Camera: Topcon TRC-NW8: 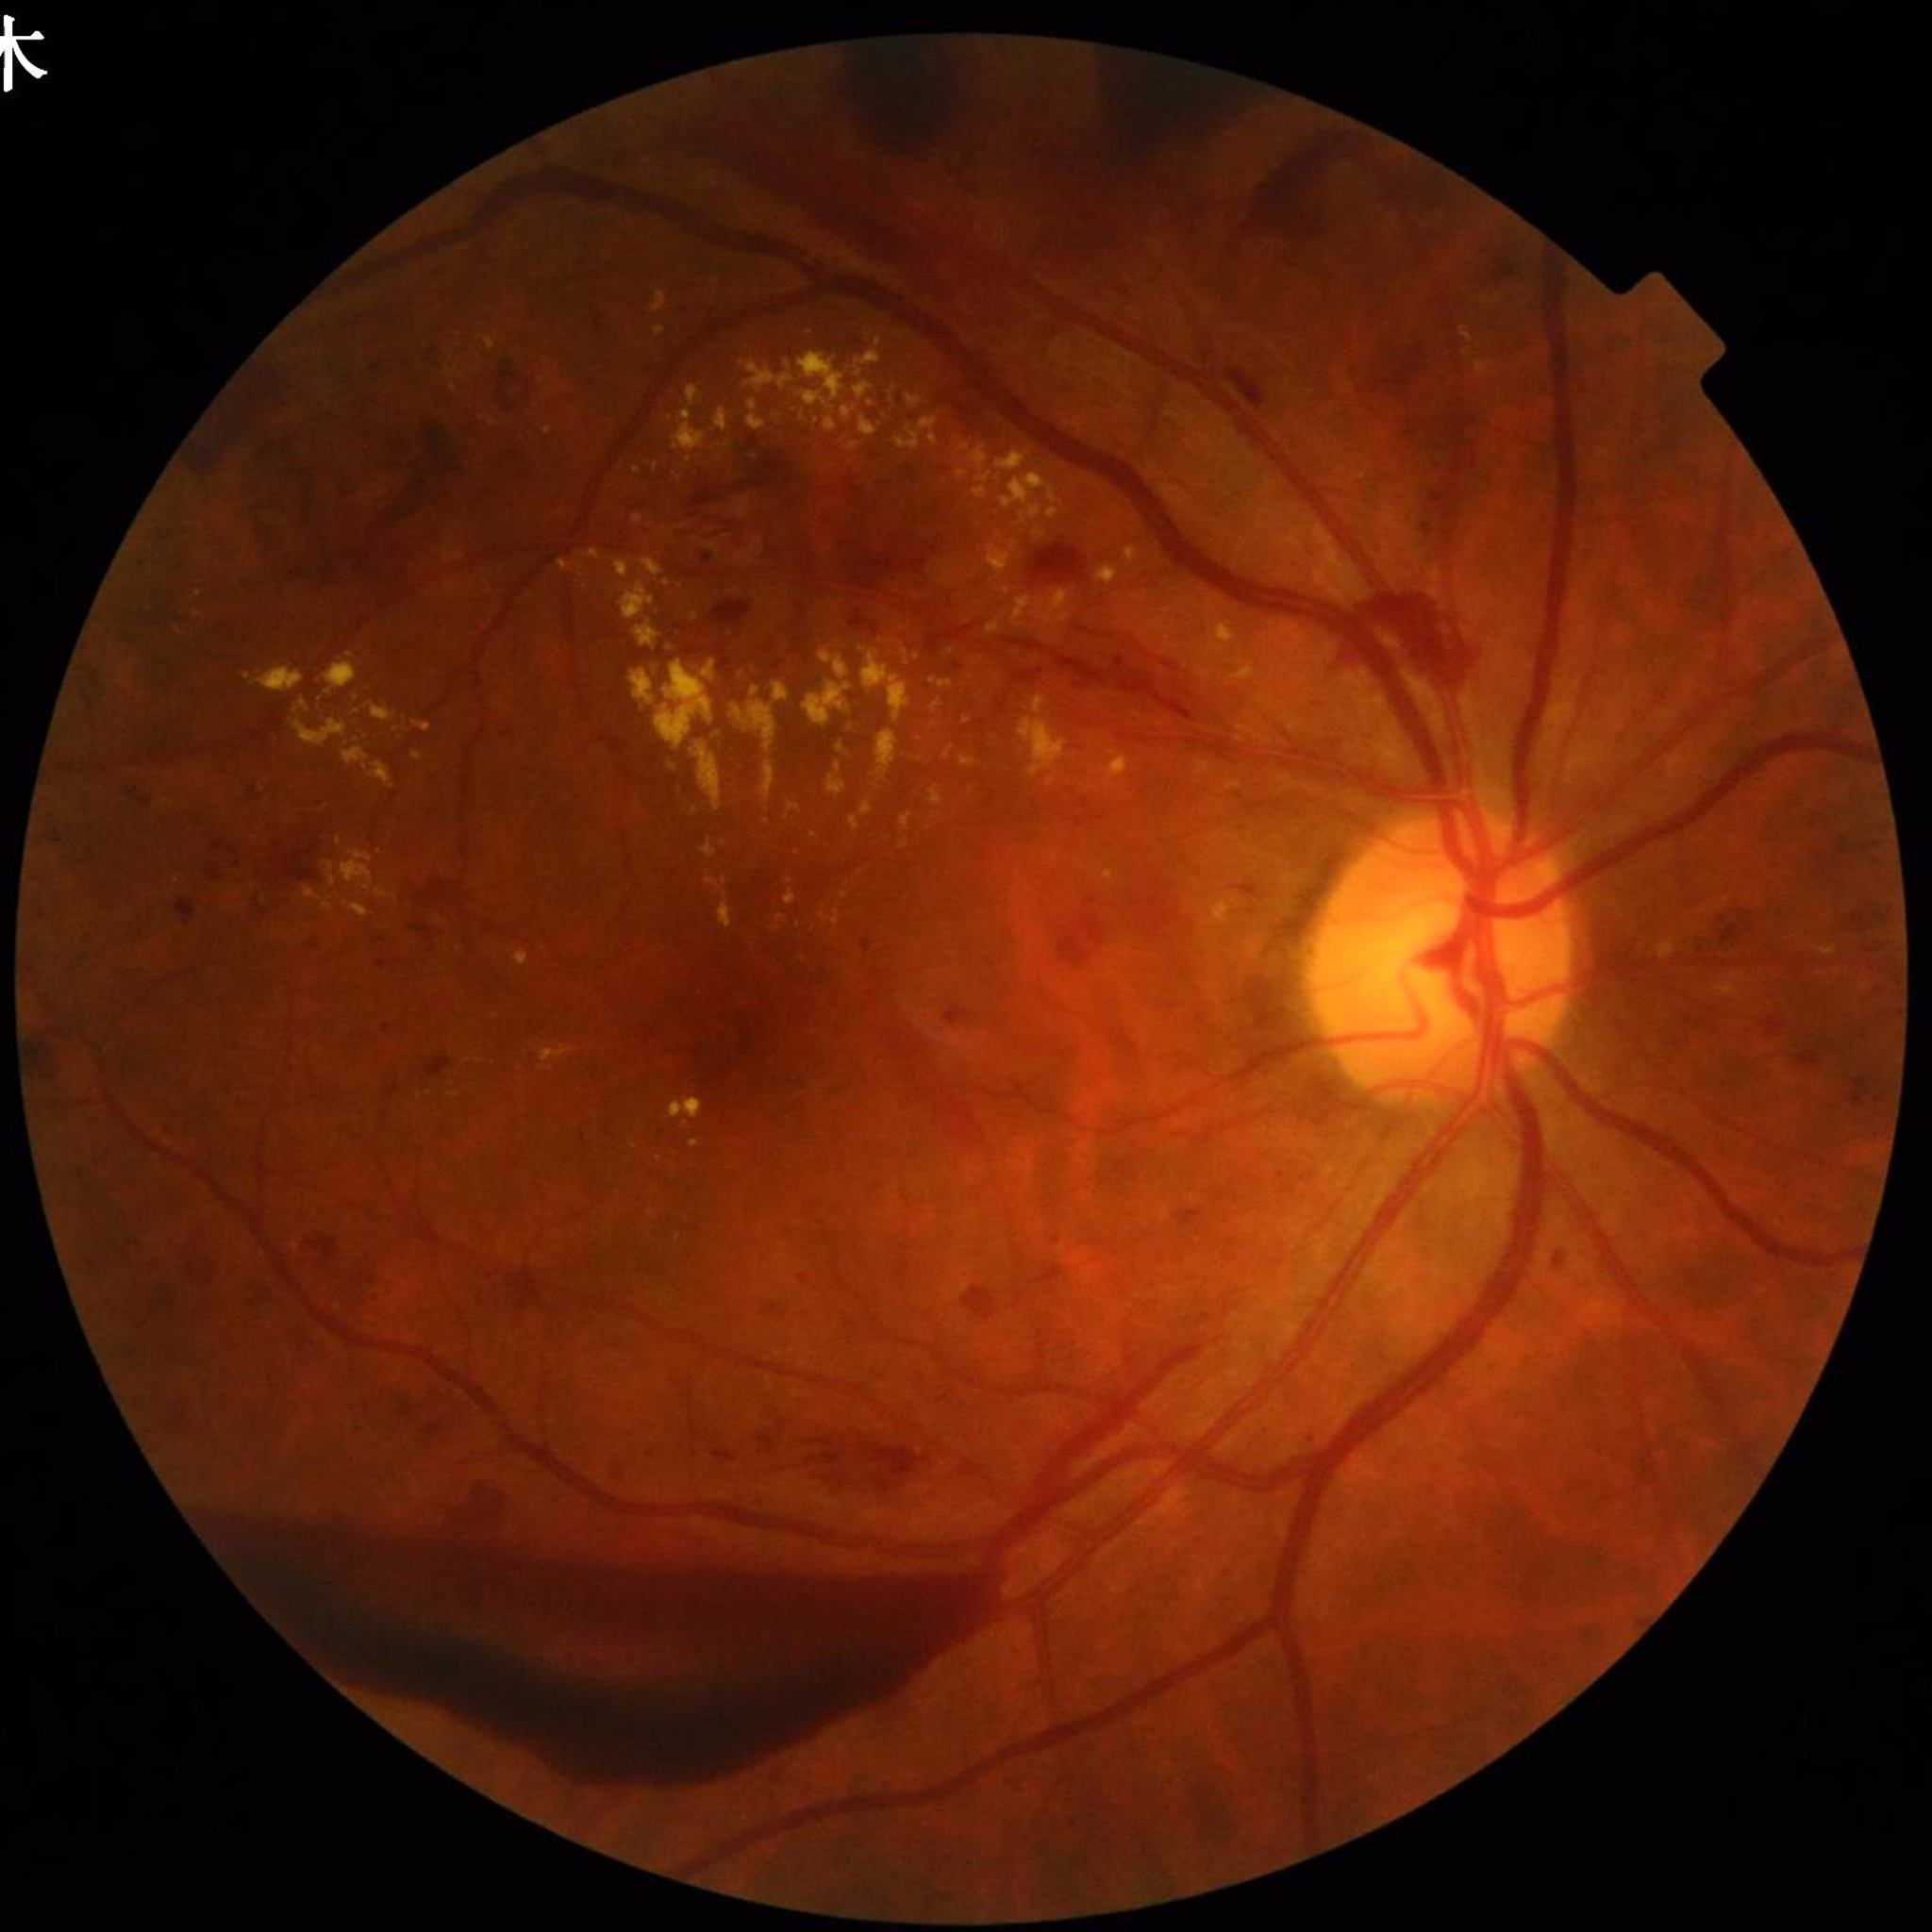 diagnosis: diabetic retinopathy